Infant wide-field retinal image · 640 by 480 pixels
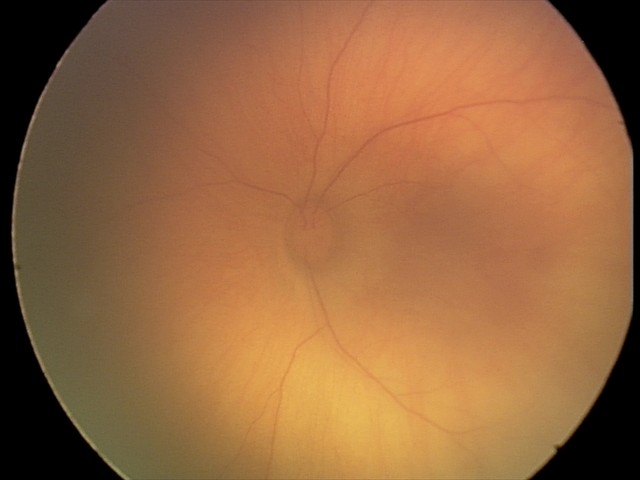

Screening examination consistent with retinal hemorrhages.